Modified Davis classification: 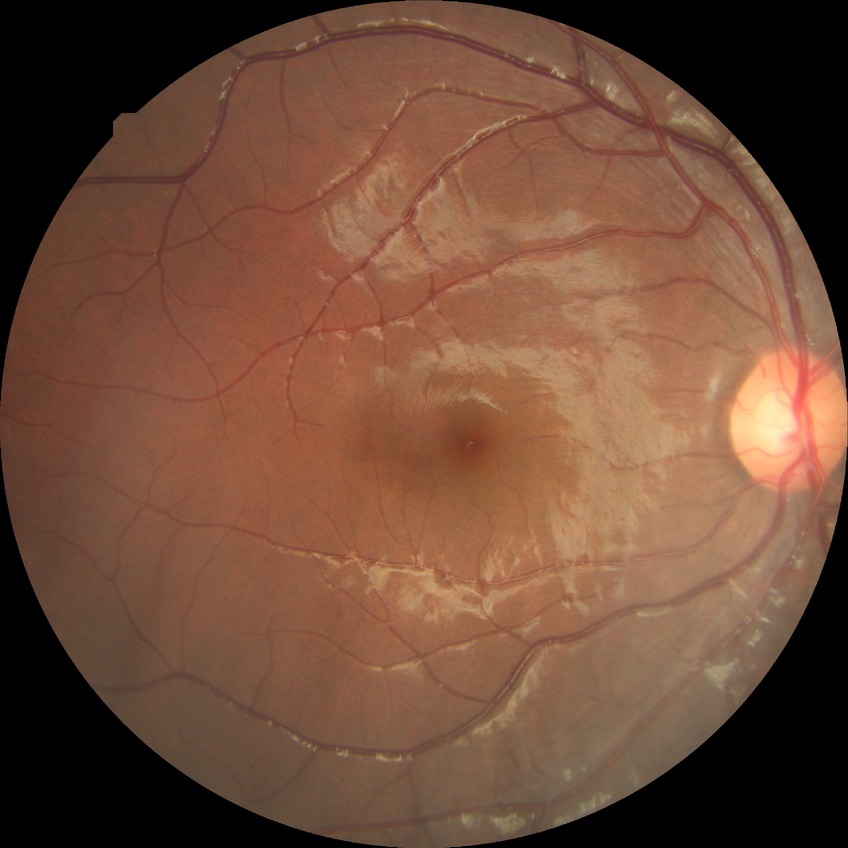

  davis_grade: no diabetic retinopathy